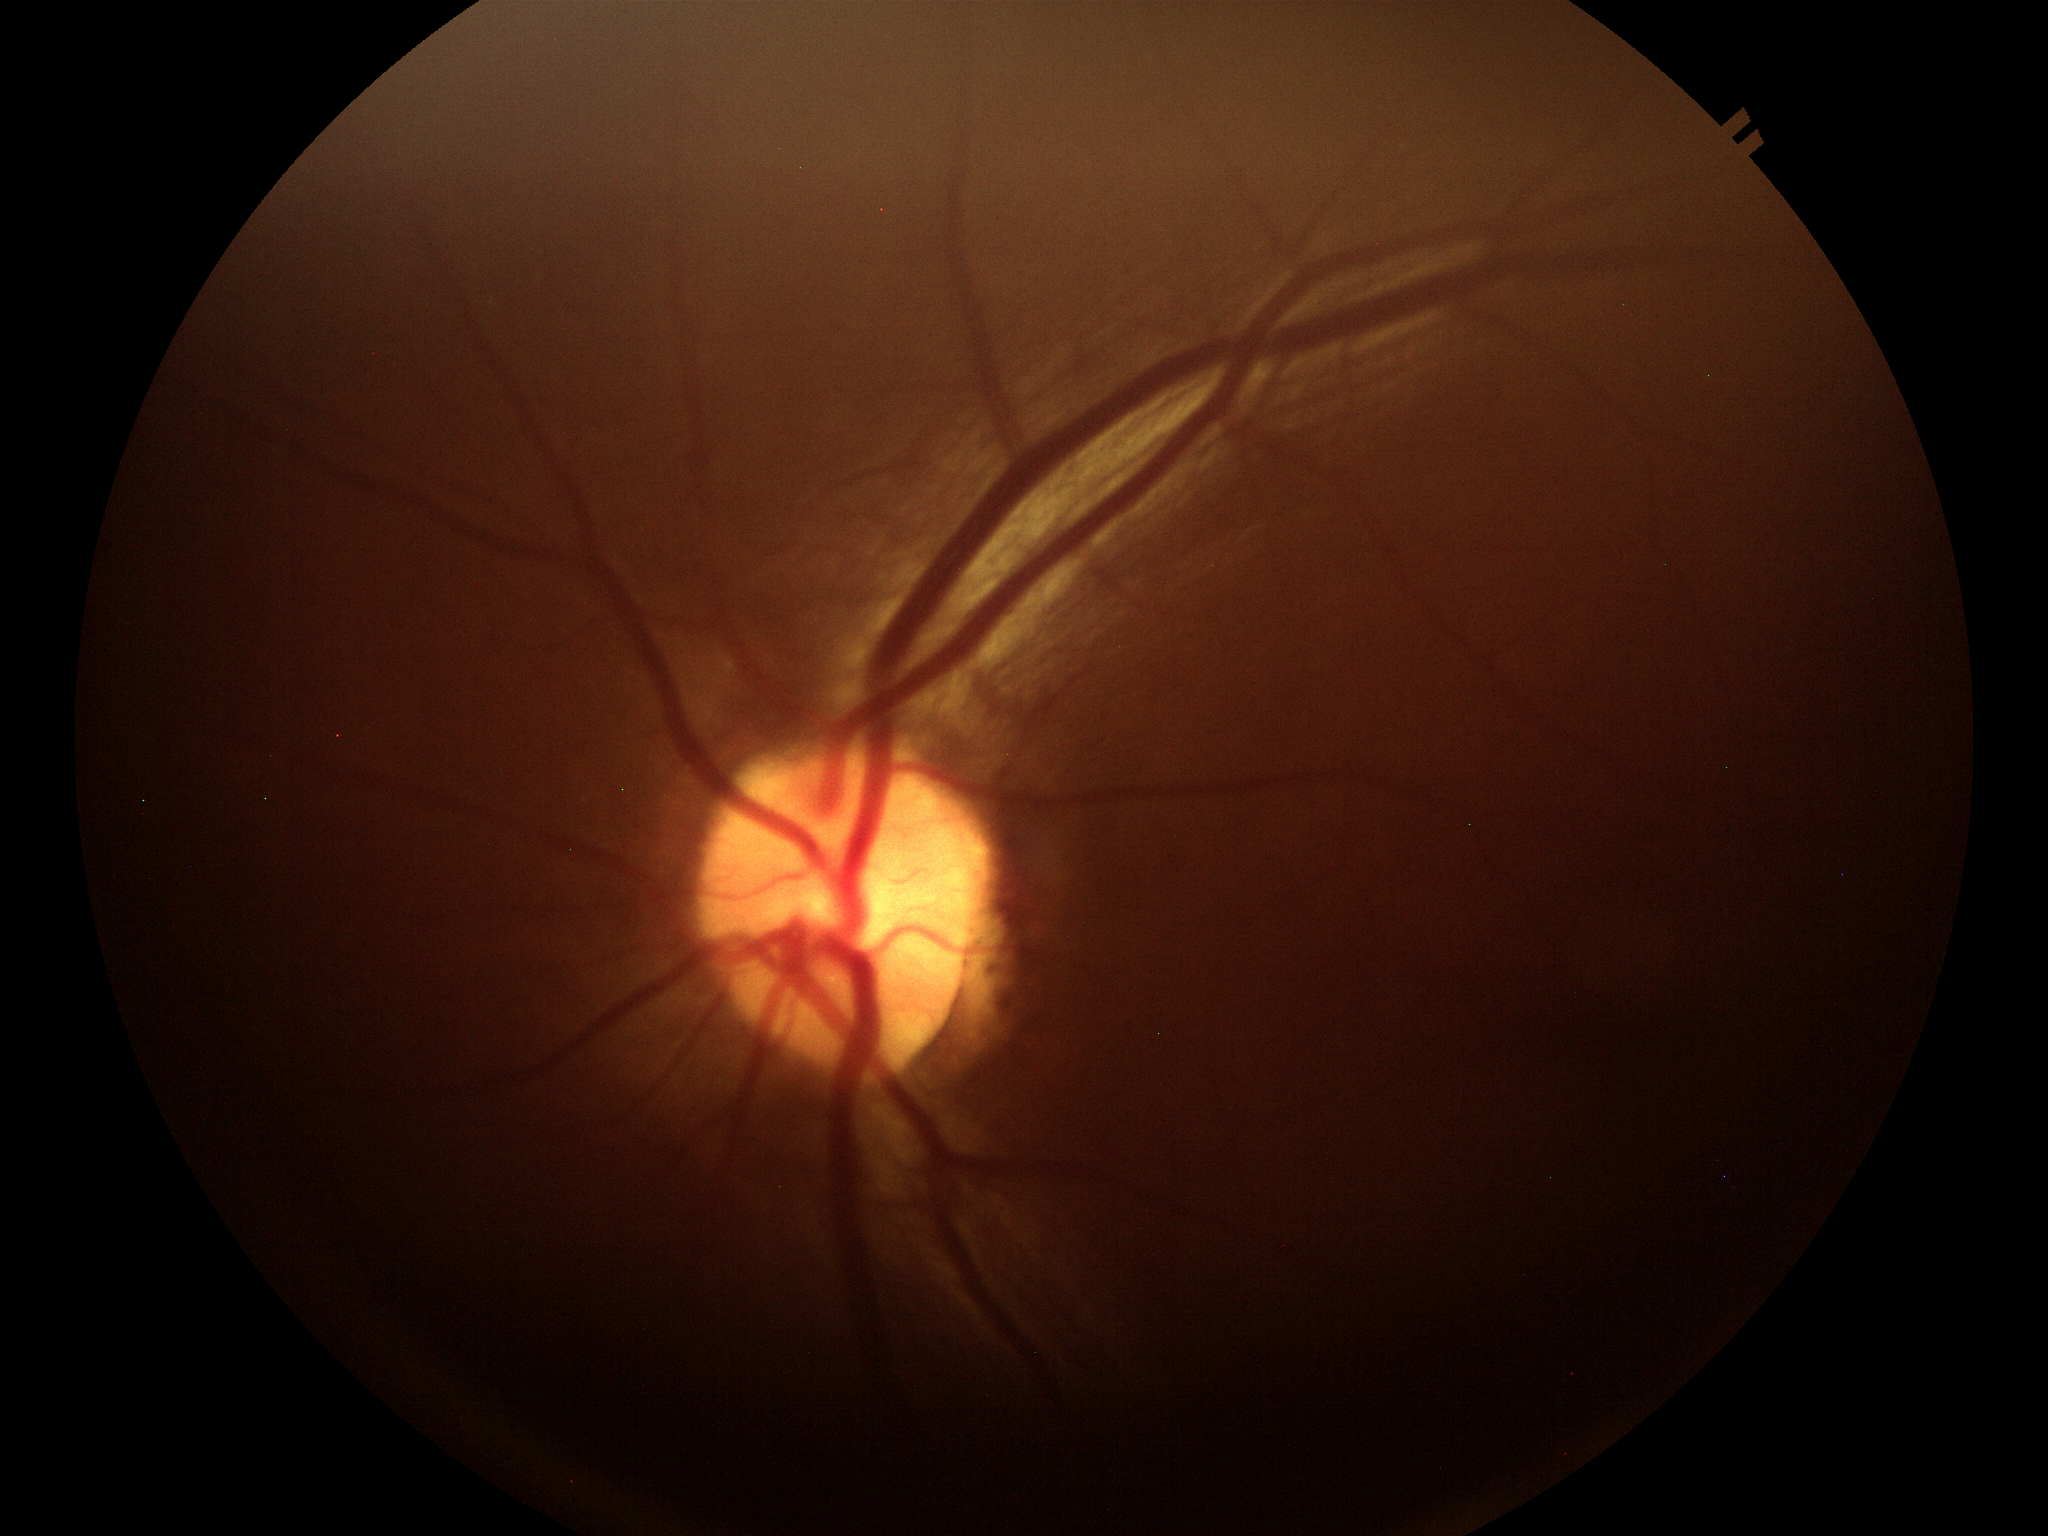
{
  "hcdr": "0.45",
  "vcdr": "0.47",
  "glaucoma_decision": "negative"
}